45-degree field of view, 2212 by 1672 pixels — 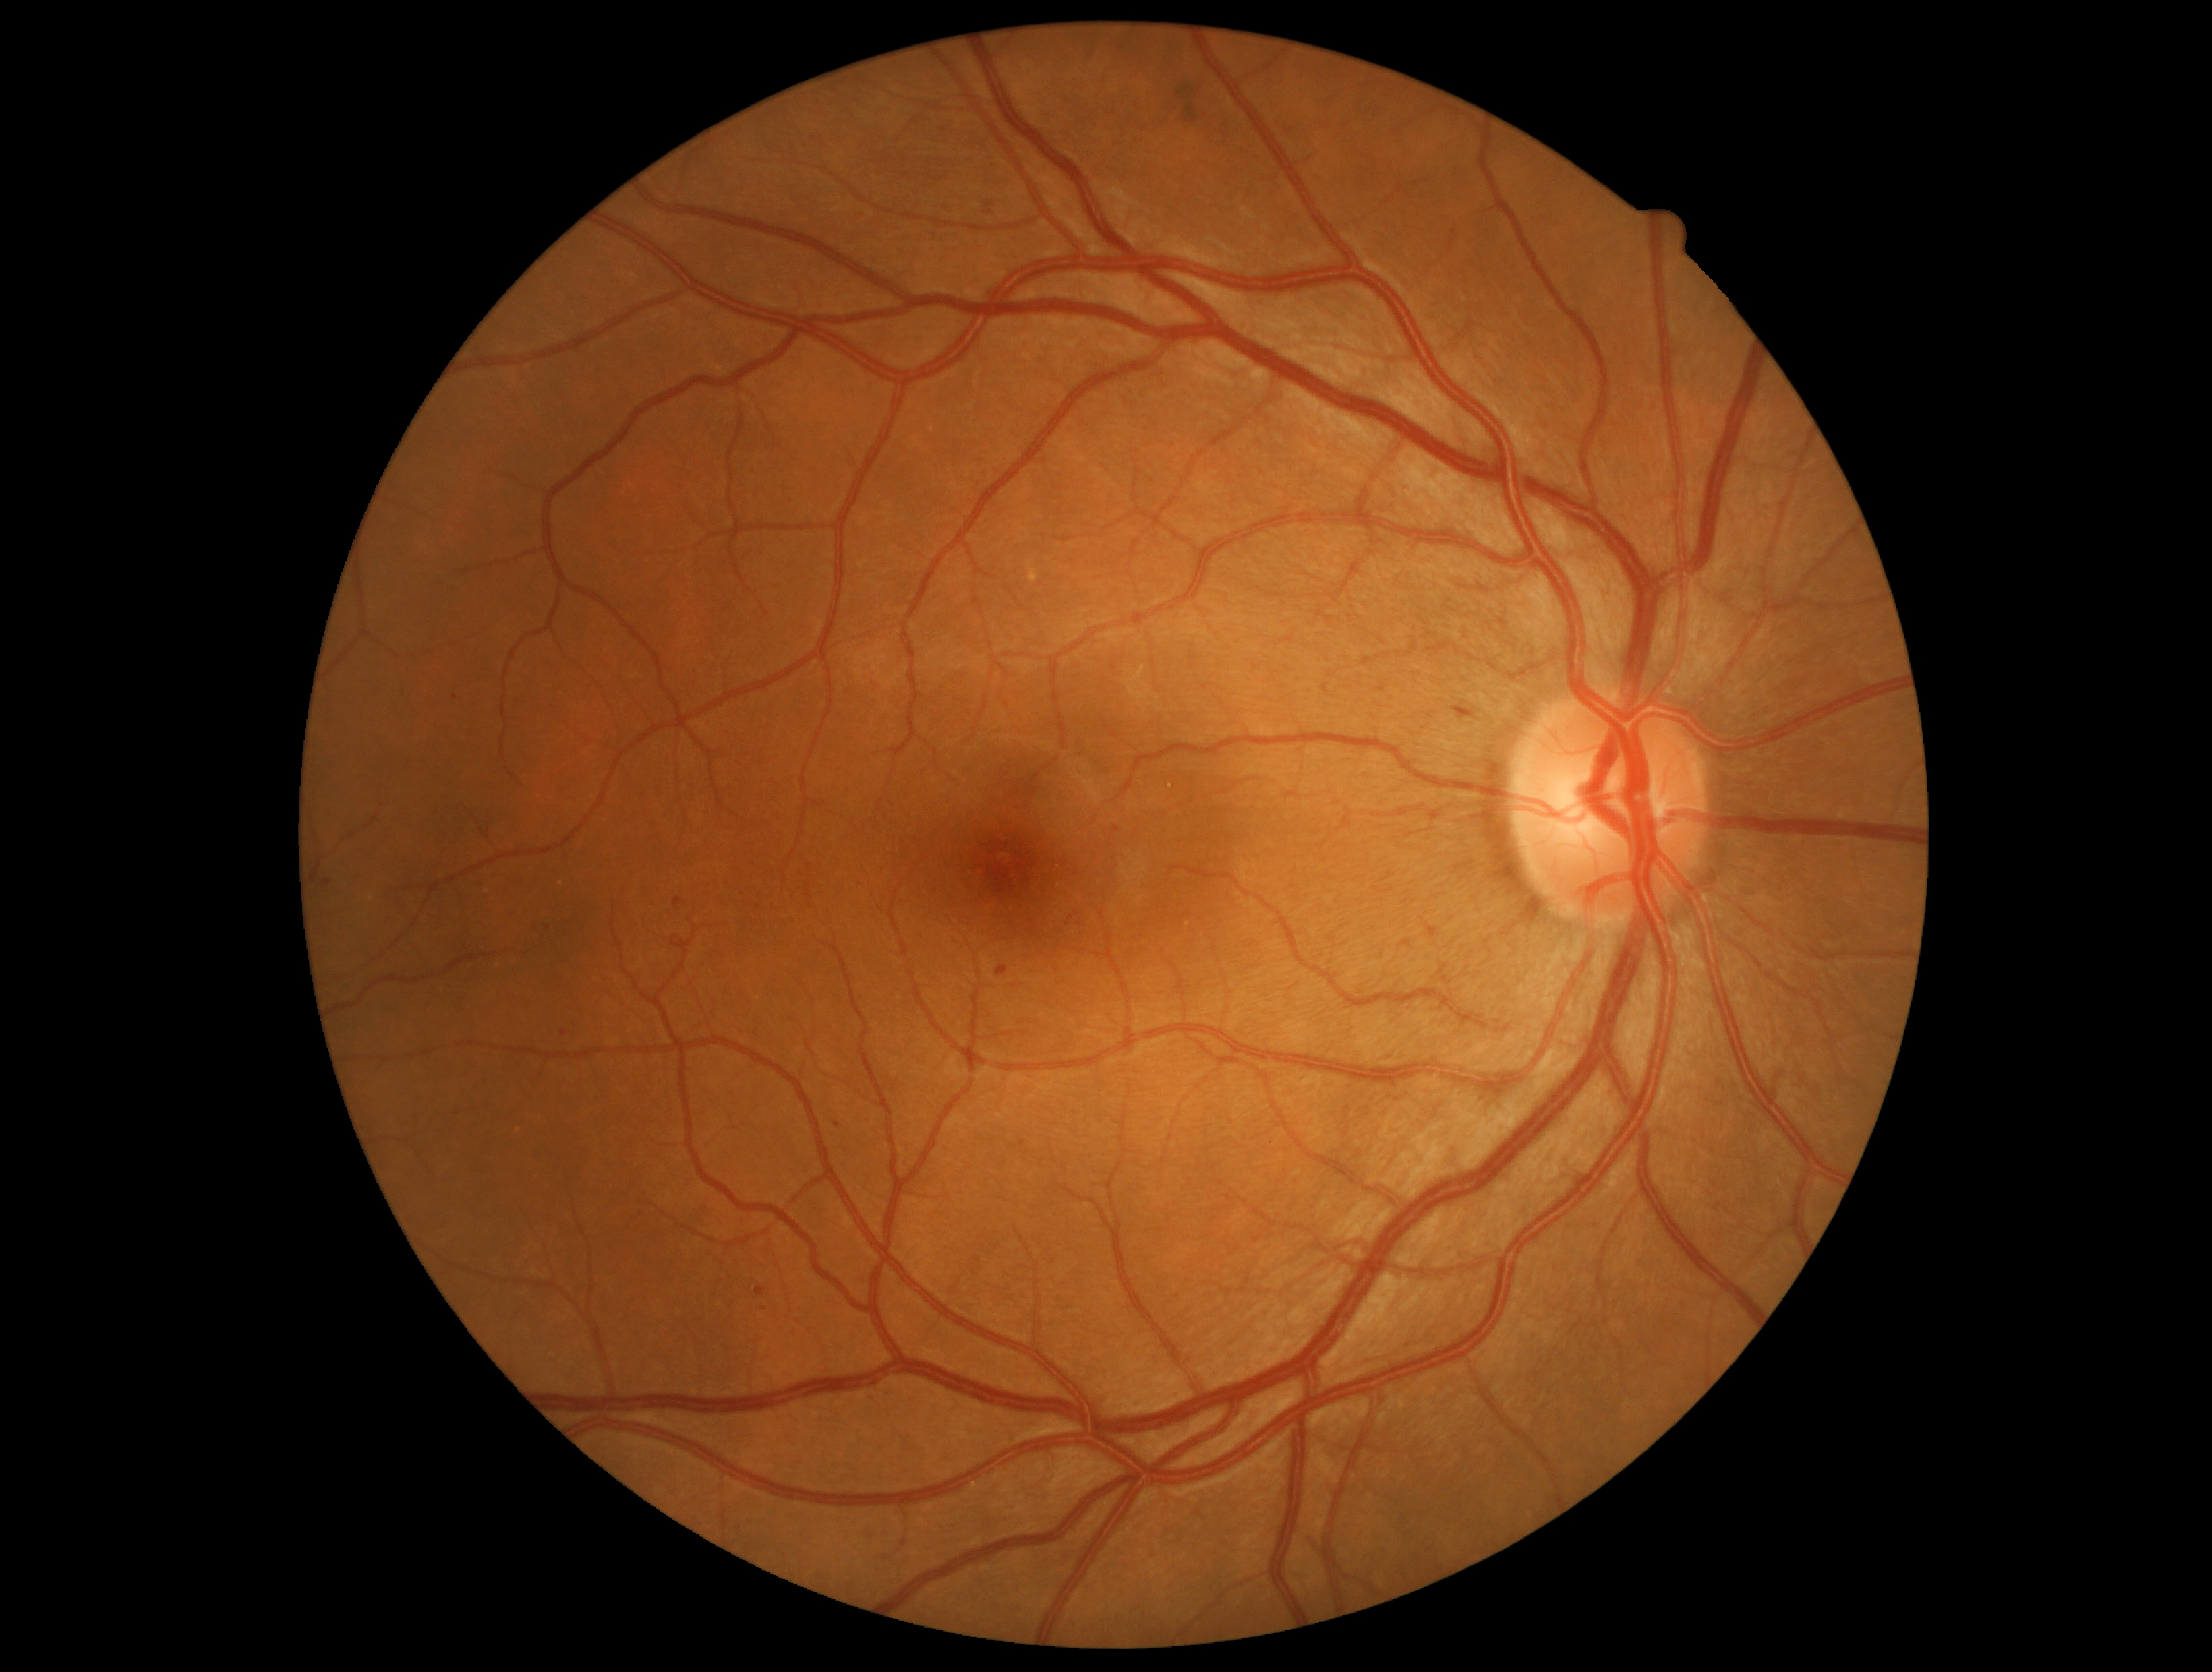 DR class@non-proliferative diabetic retinopathy; diabetic retinopathy (DR)@moderate NPDR (grade 2).